640 by 480 pixels. Pediatric wide-field fundus photograph: 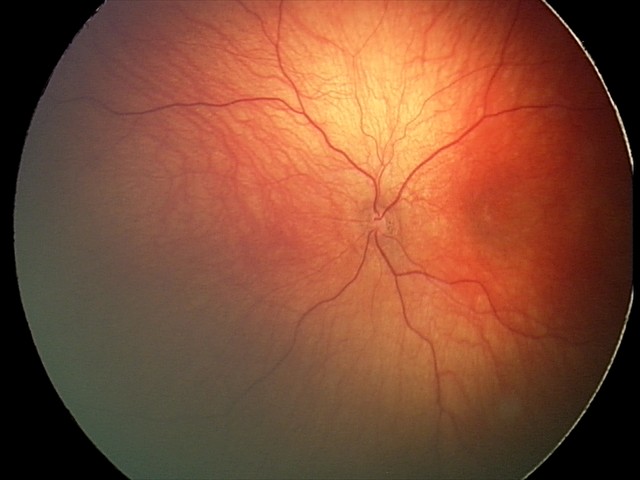 Assessment: optic nerve hypoplasia